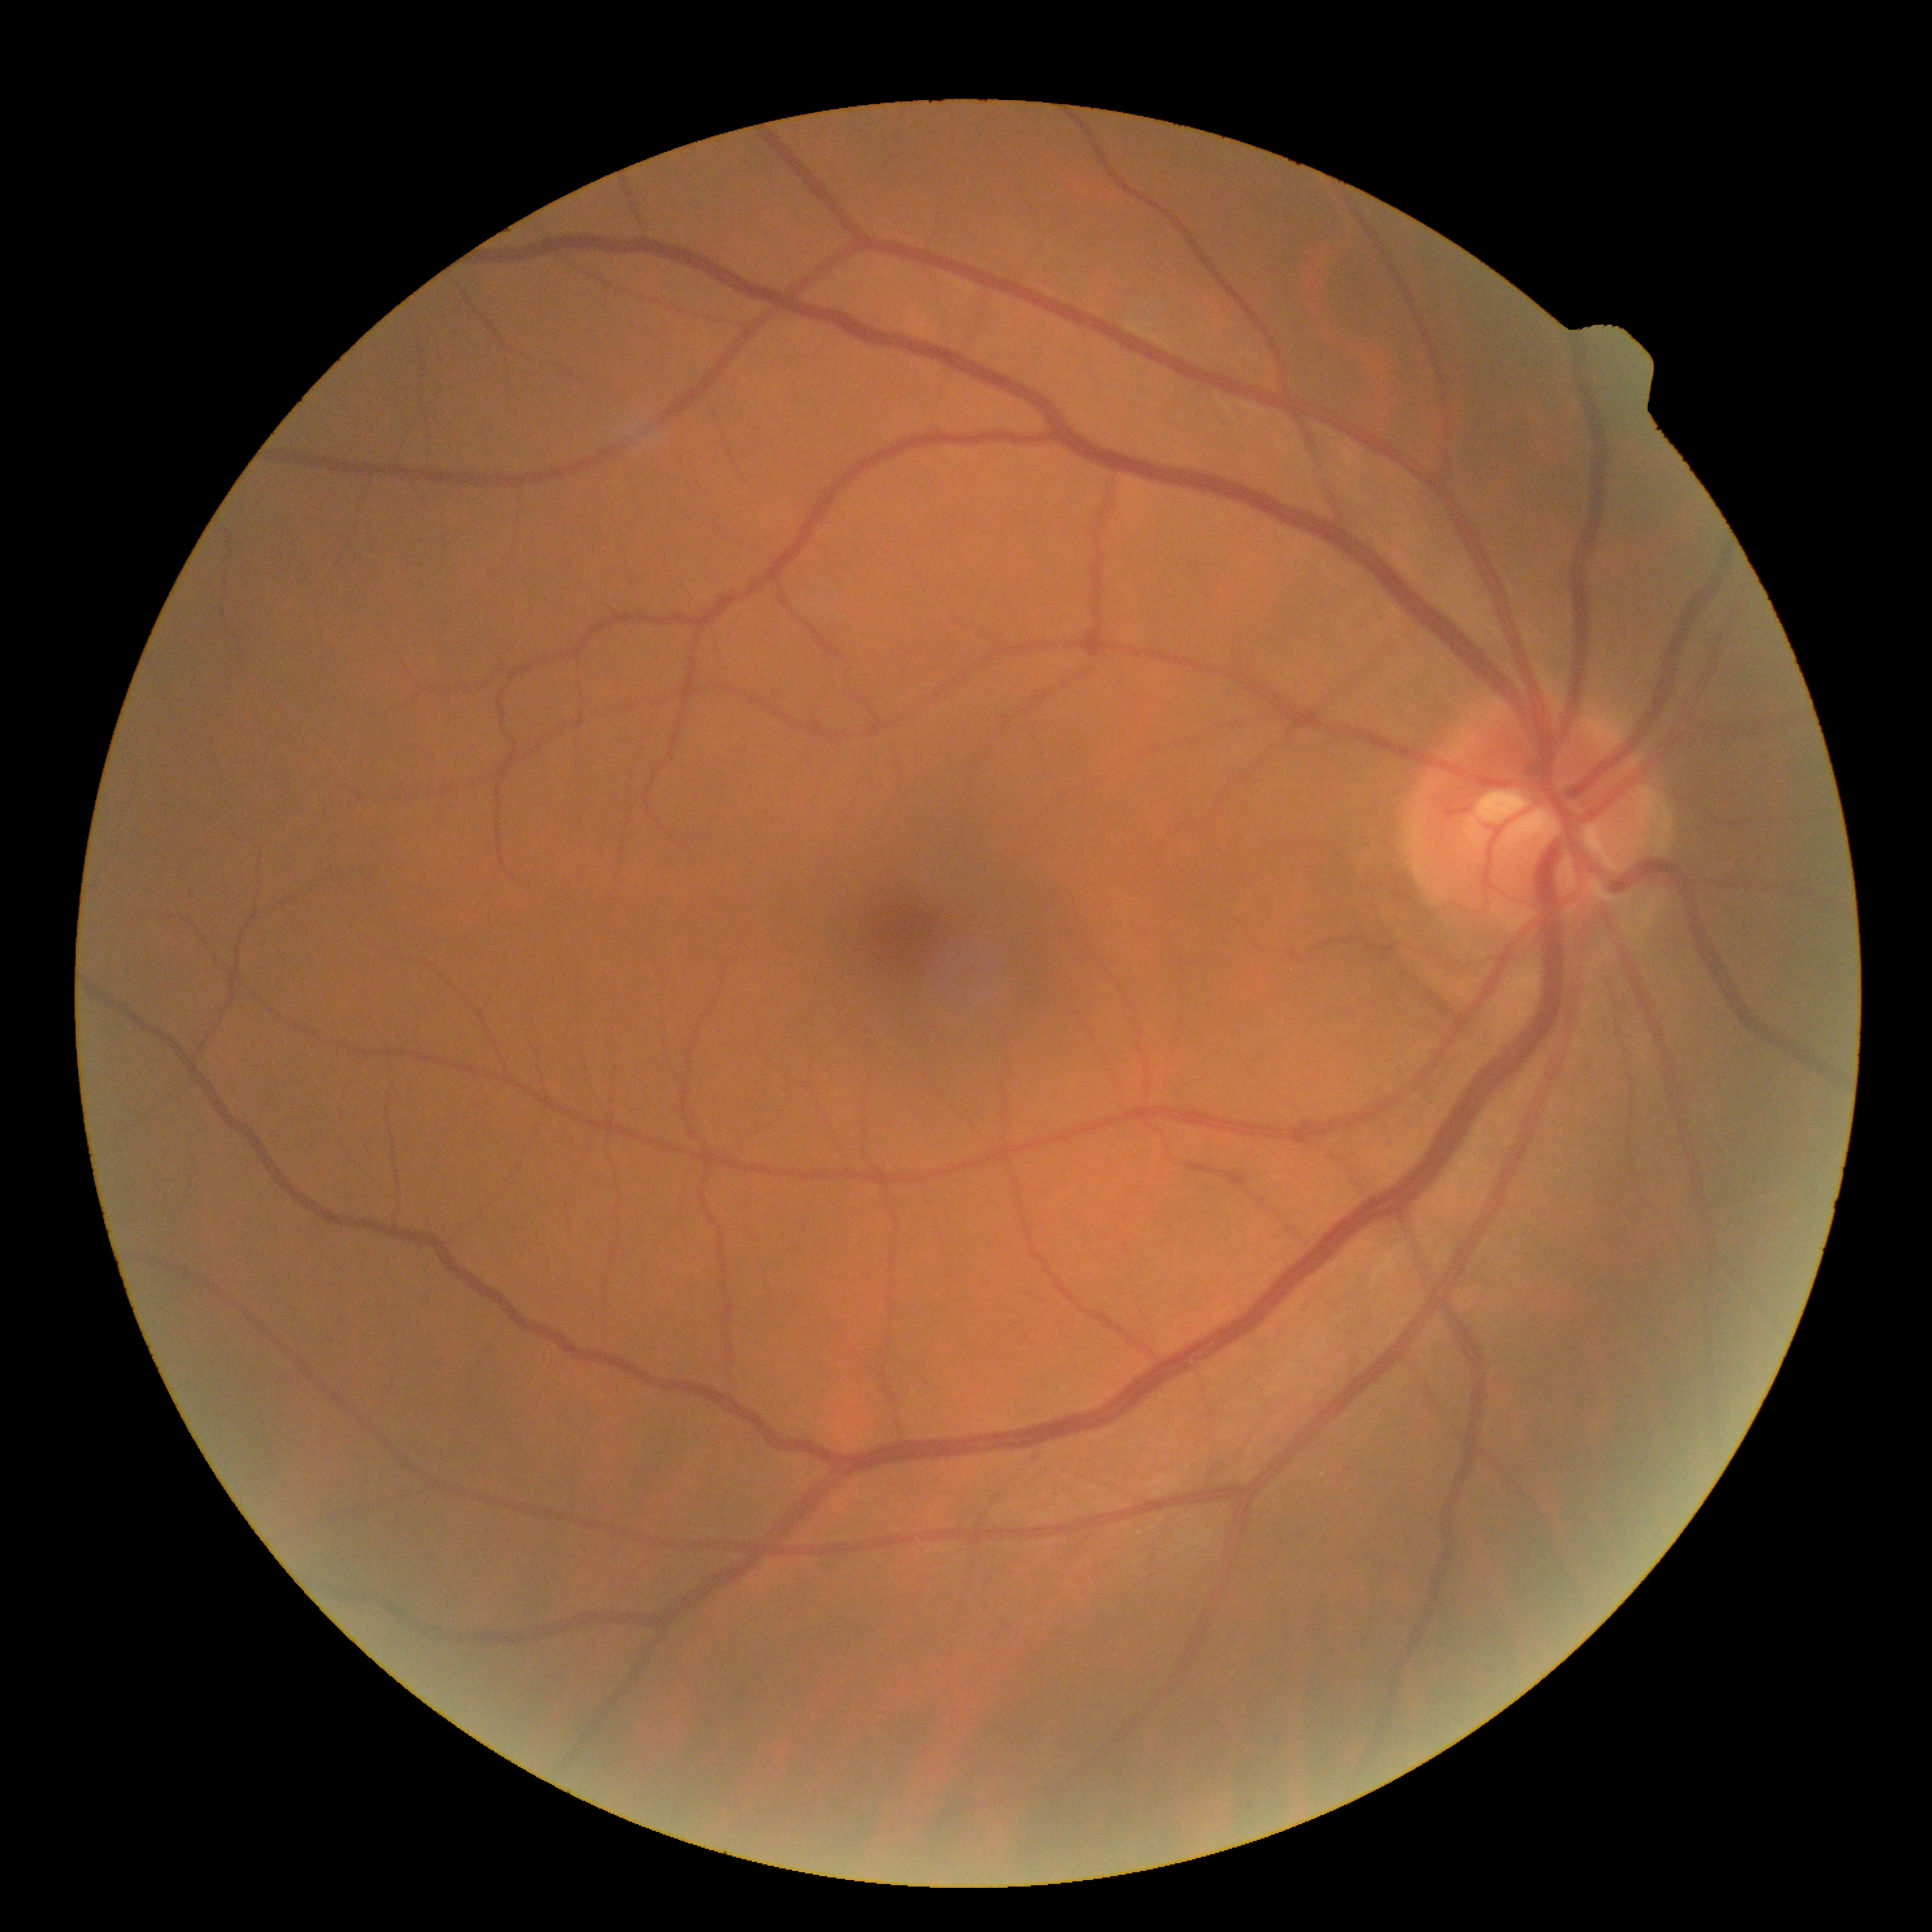 retinopathy grade=0/4.